Retinal fundus photograph · 45° field of view — 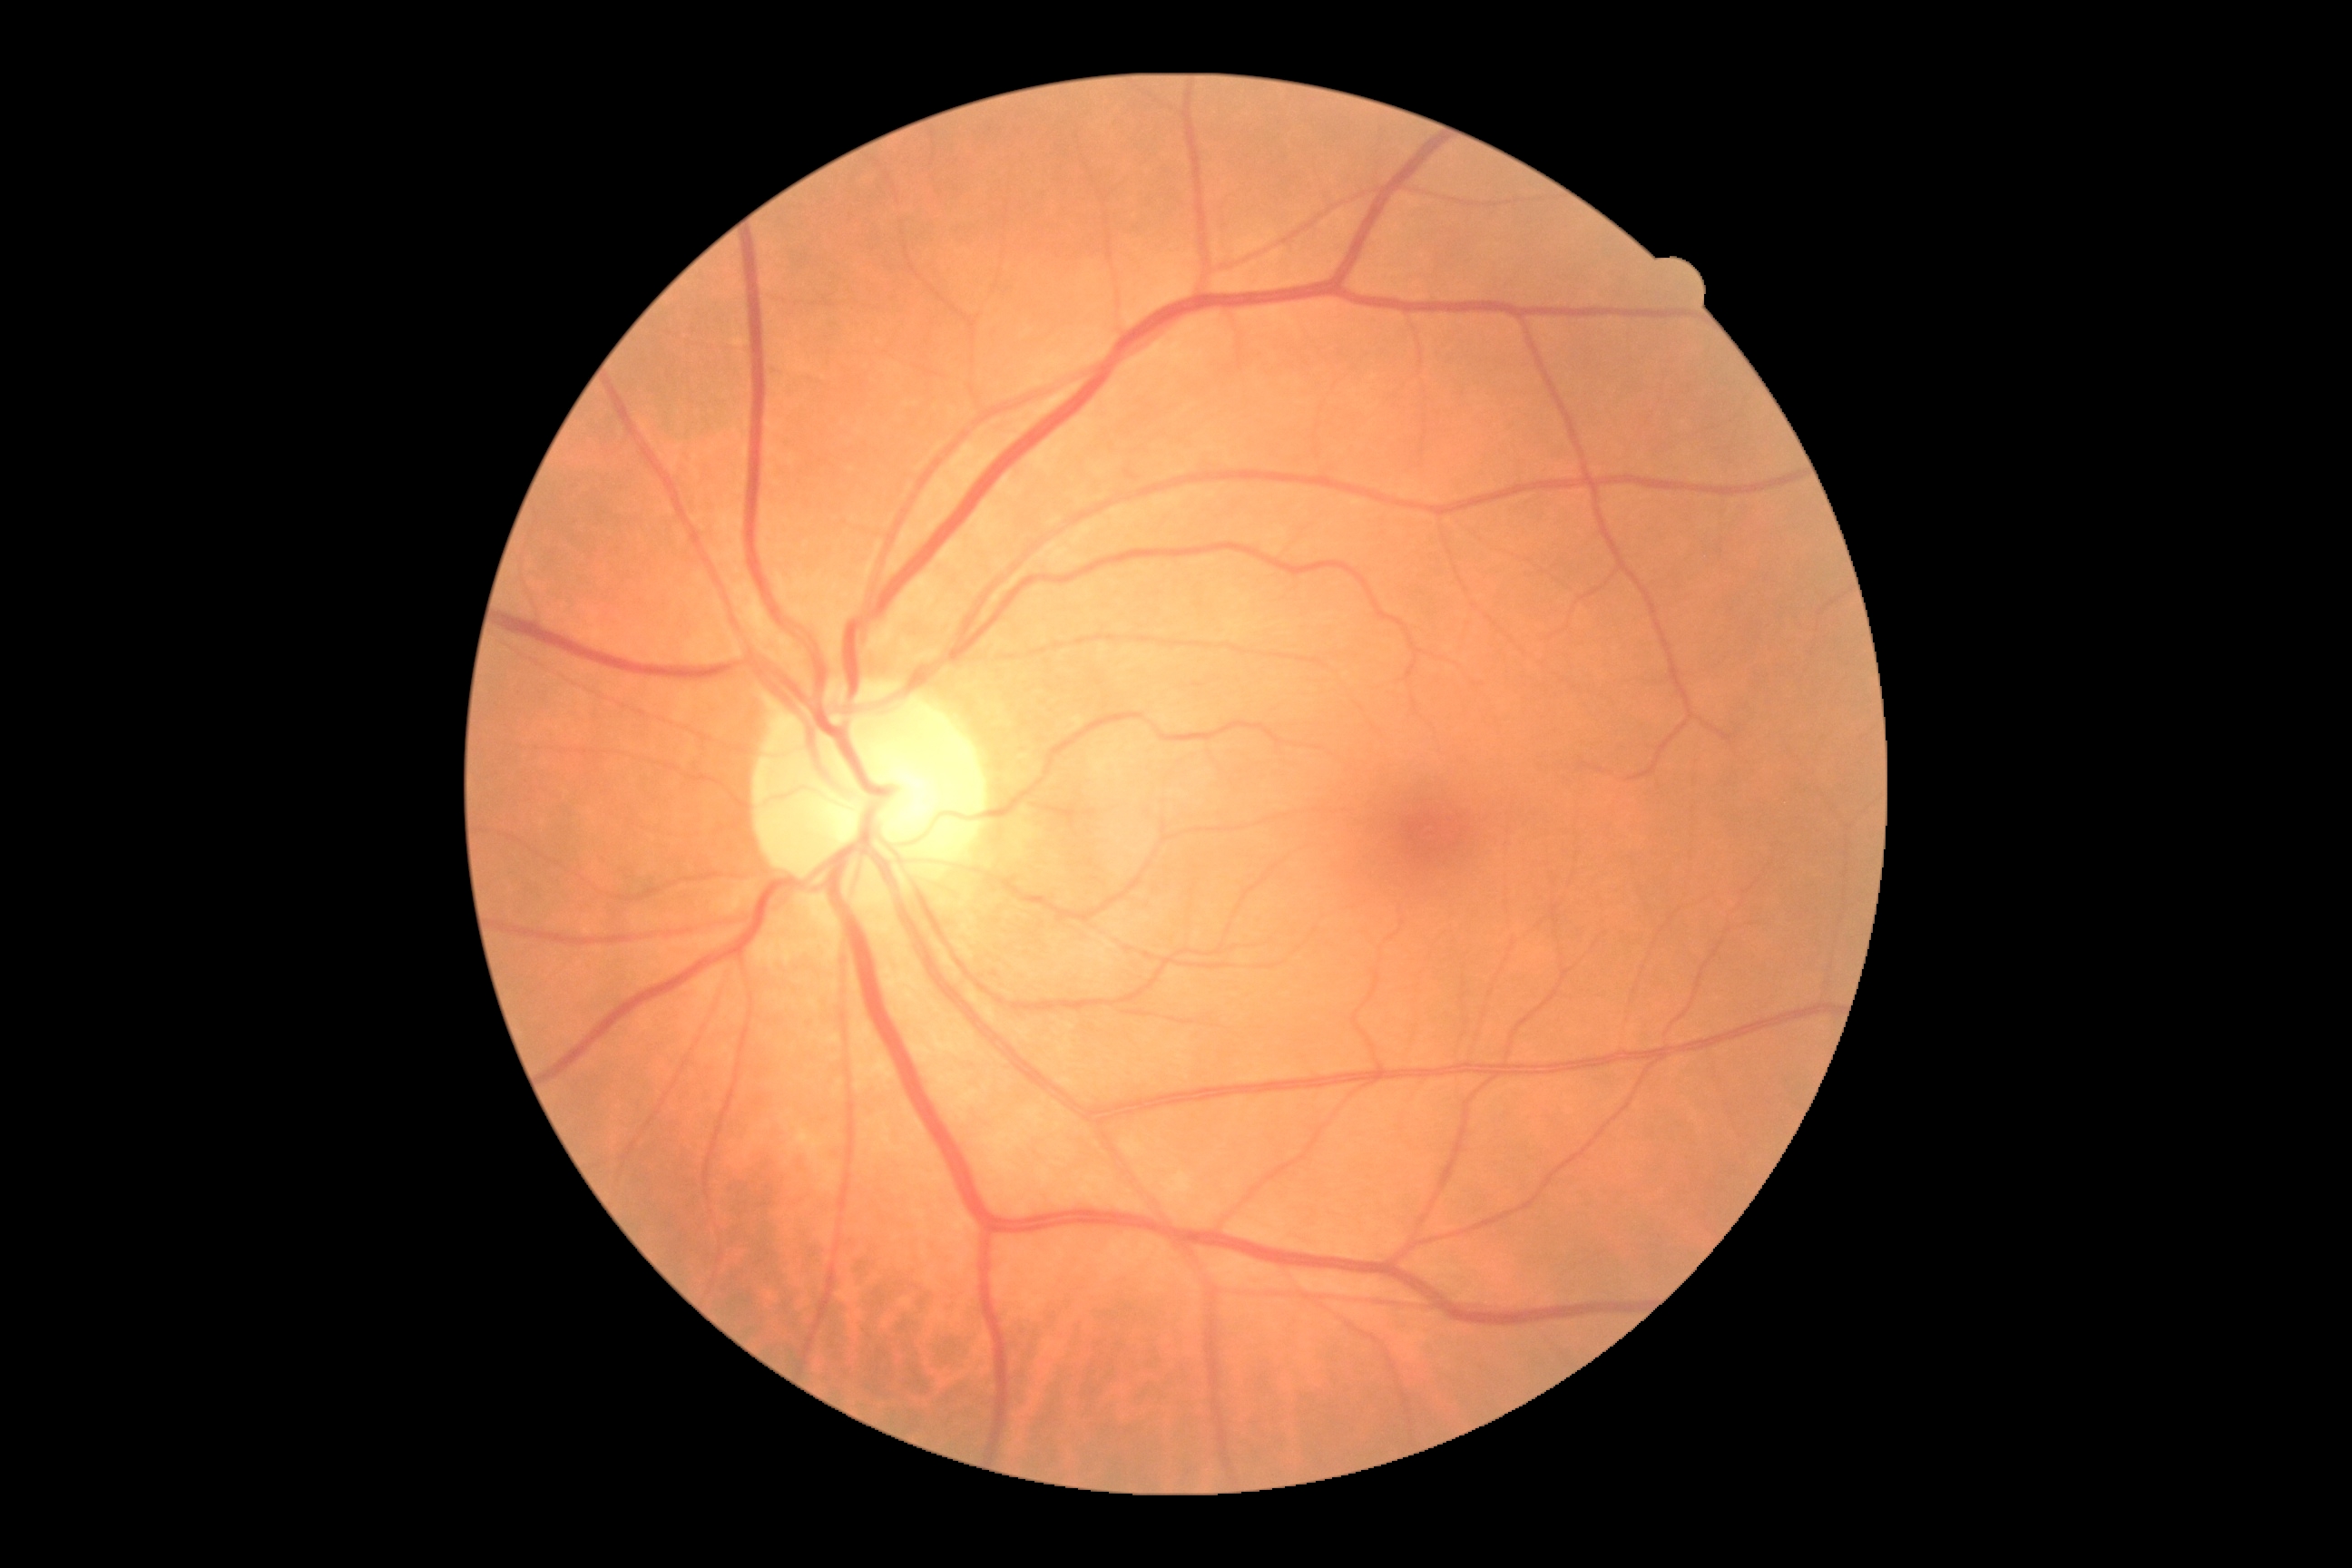

Diabetic retinopathy grade: 0/4. No DR findings.